2212x1659:
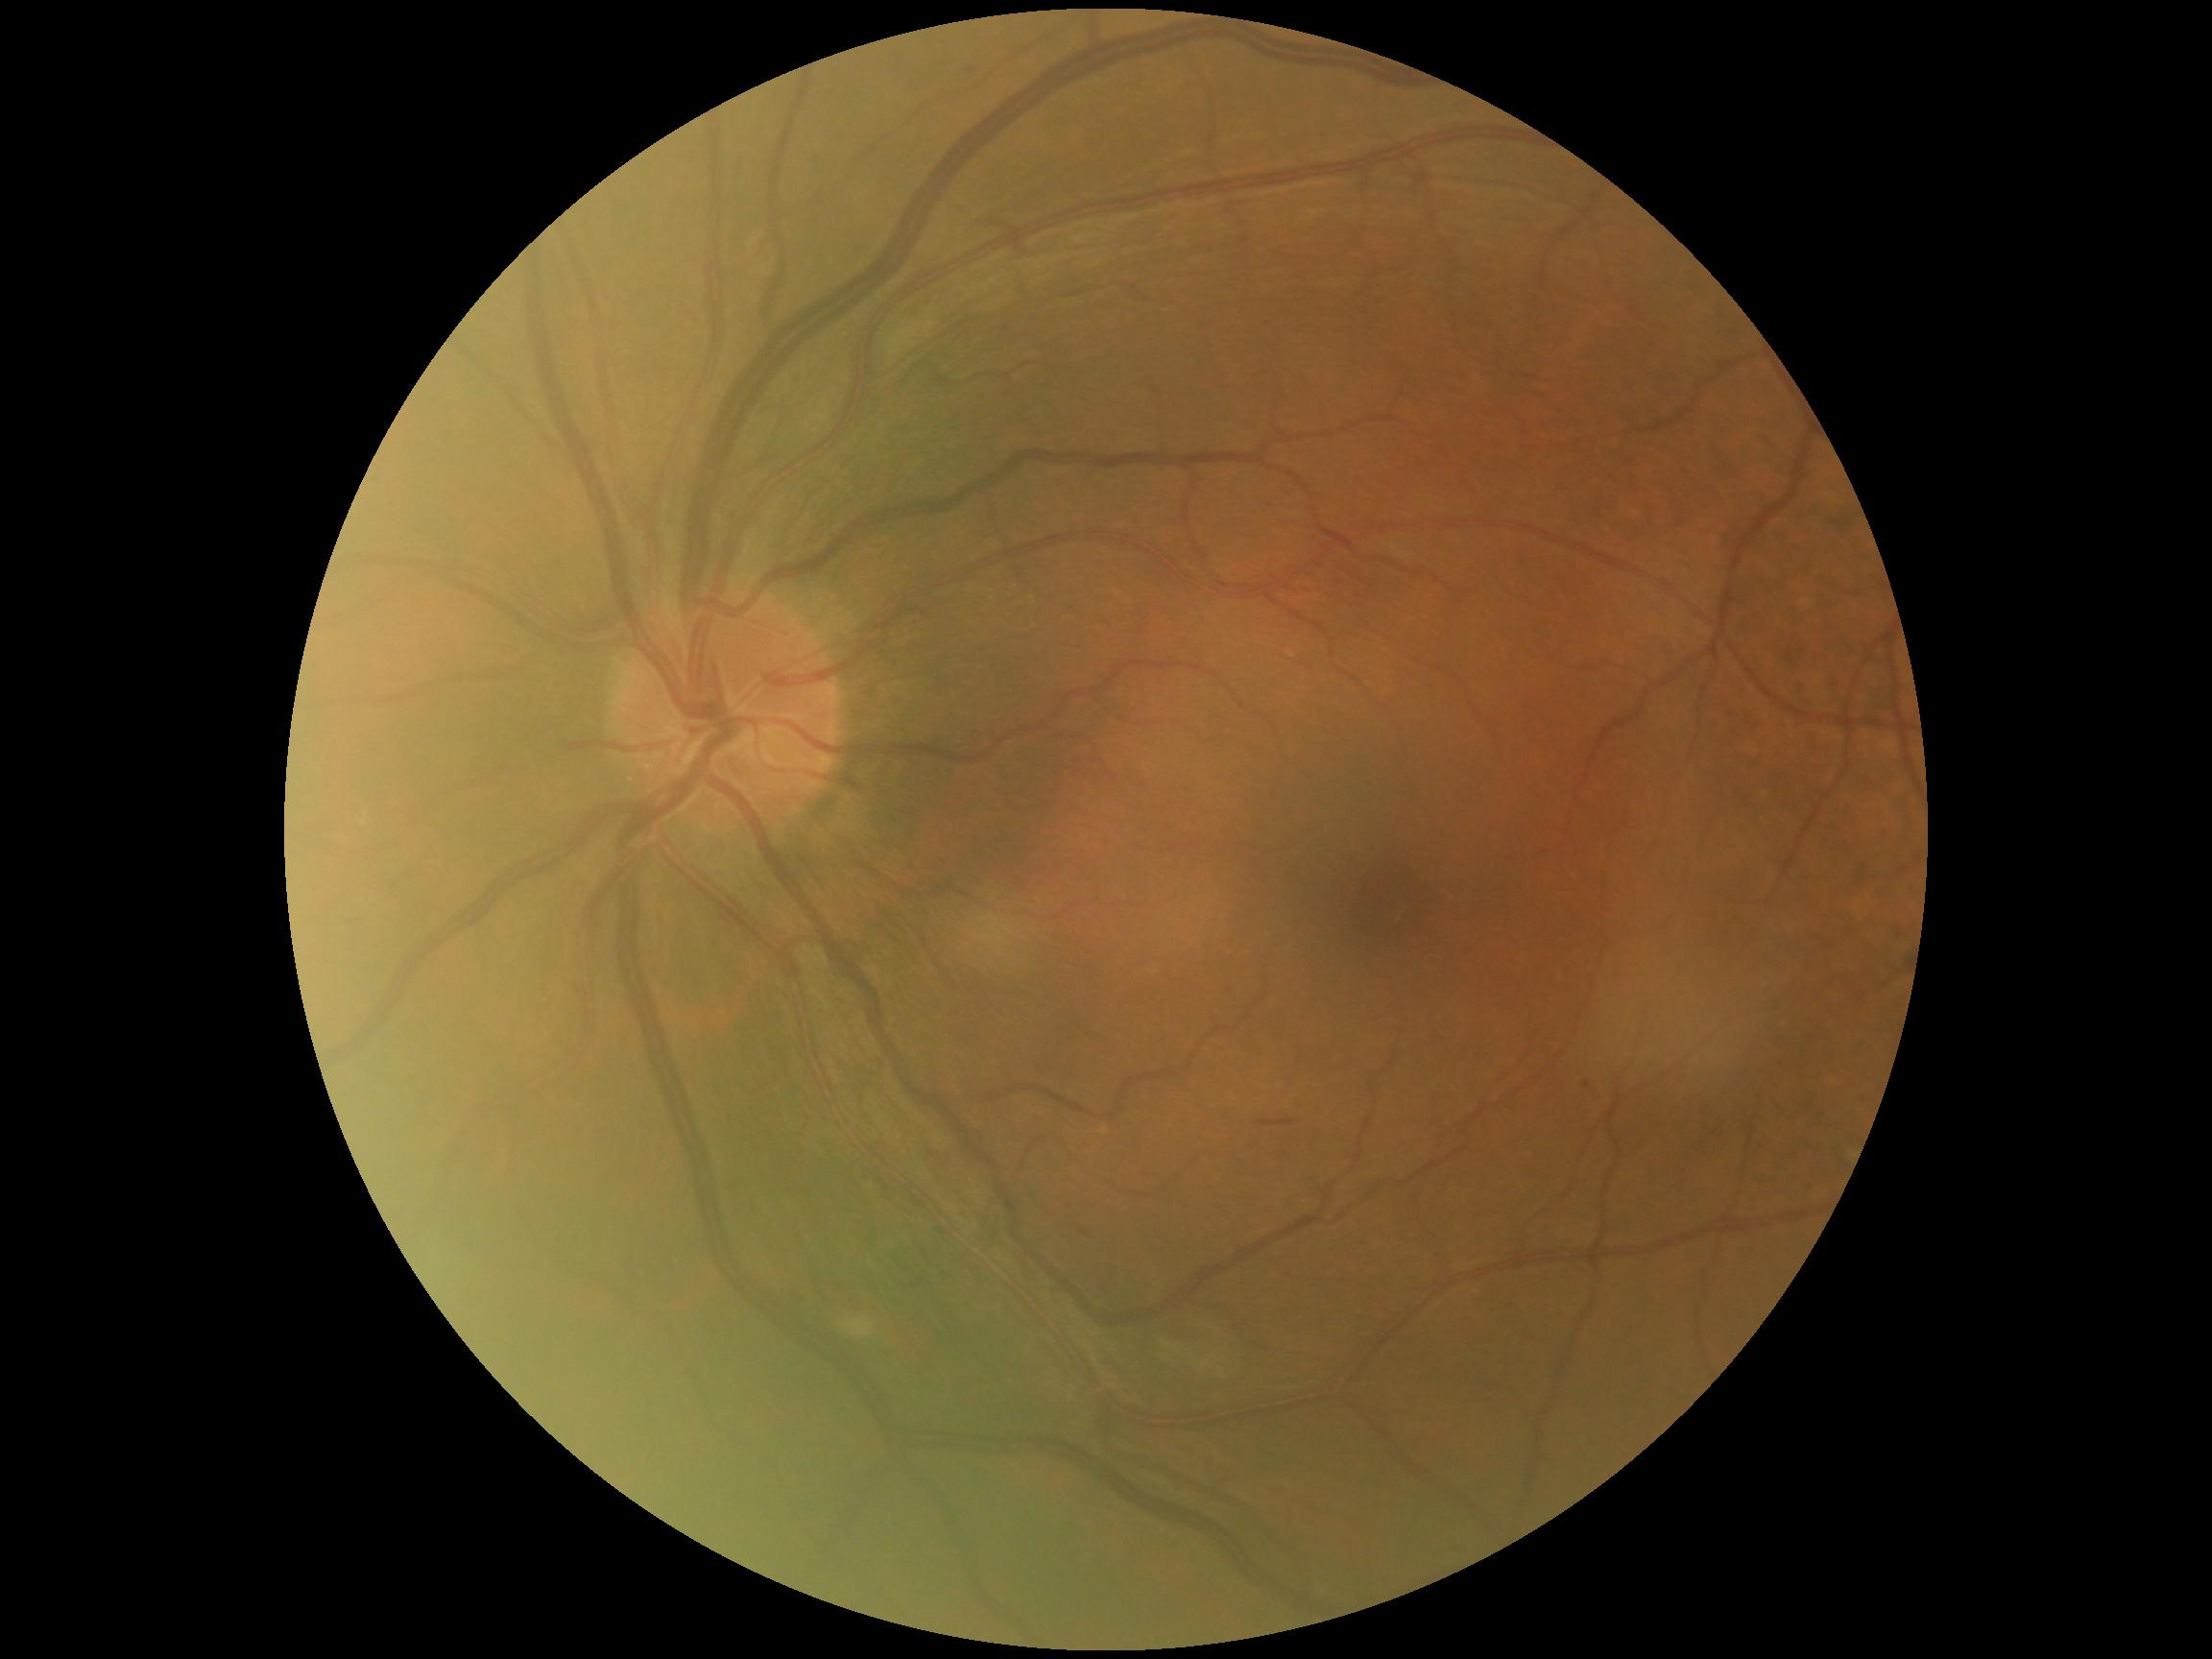
DR severity: moderate NPDR (grade 2) — more than just microaneurysms but less than severe NPDR.